45 degree fundus photograph. Nonmydriatic fundus photograph. Acquired with a NIDEK AFC-230: 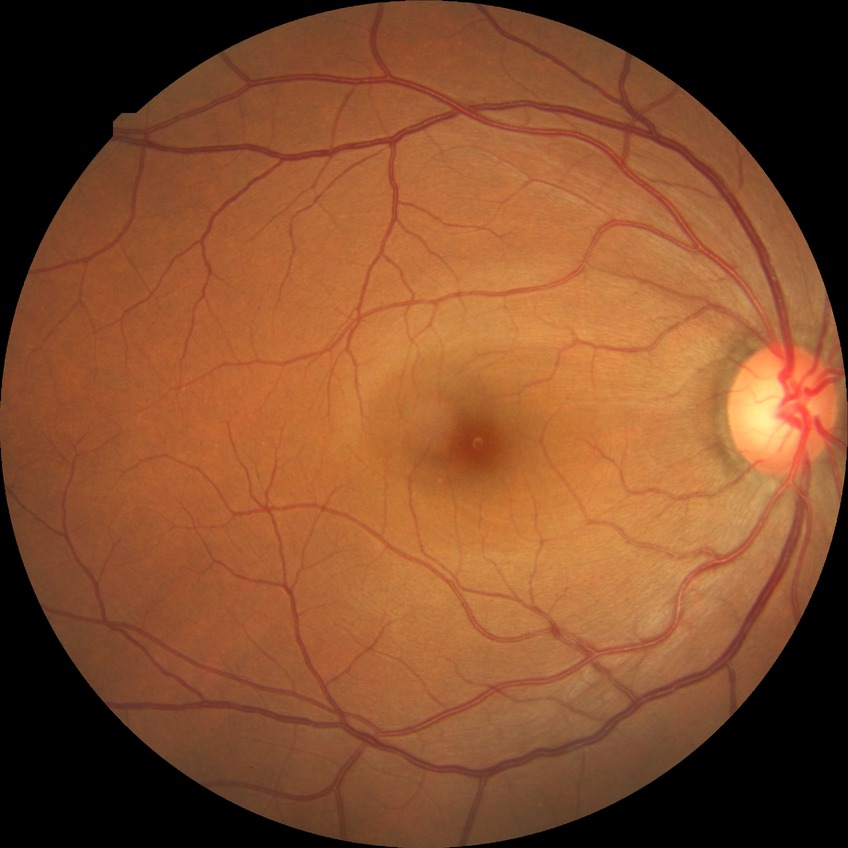
Annotations:
* DR: NDR